No pharmacologic dilation, color fundus image: 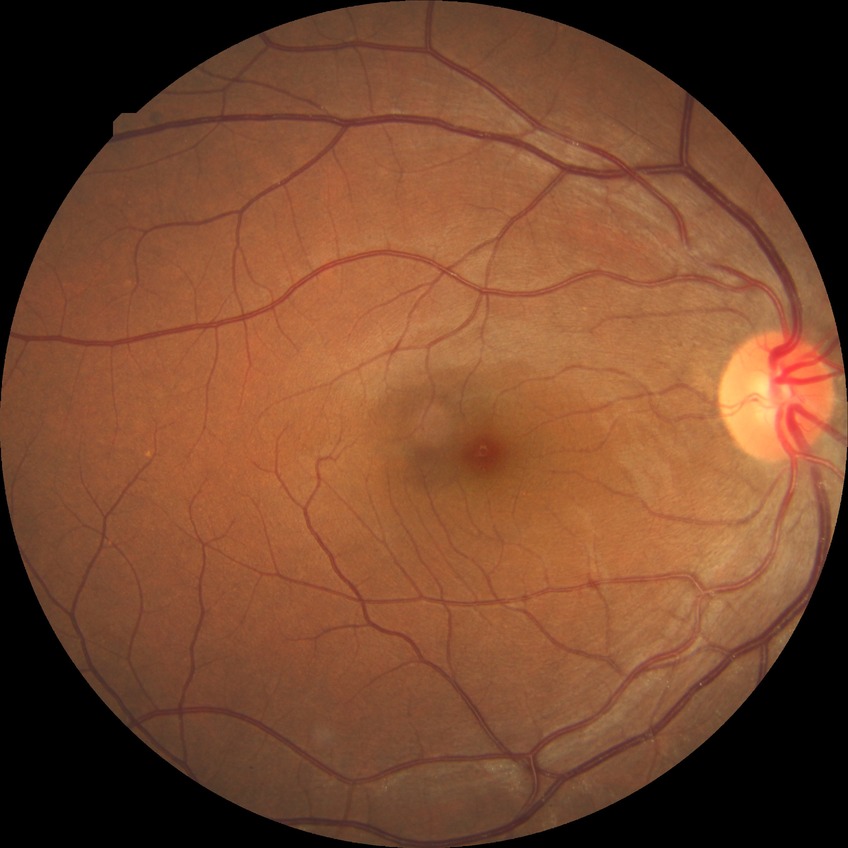

Diabetic retinopathy (DR): NDR (no diabetic retinopathy).